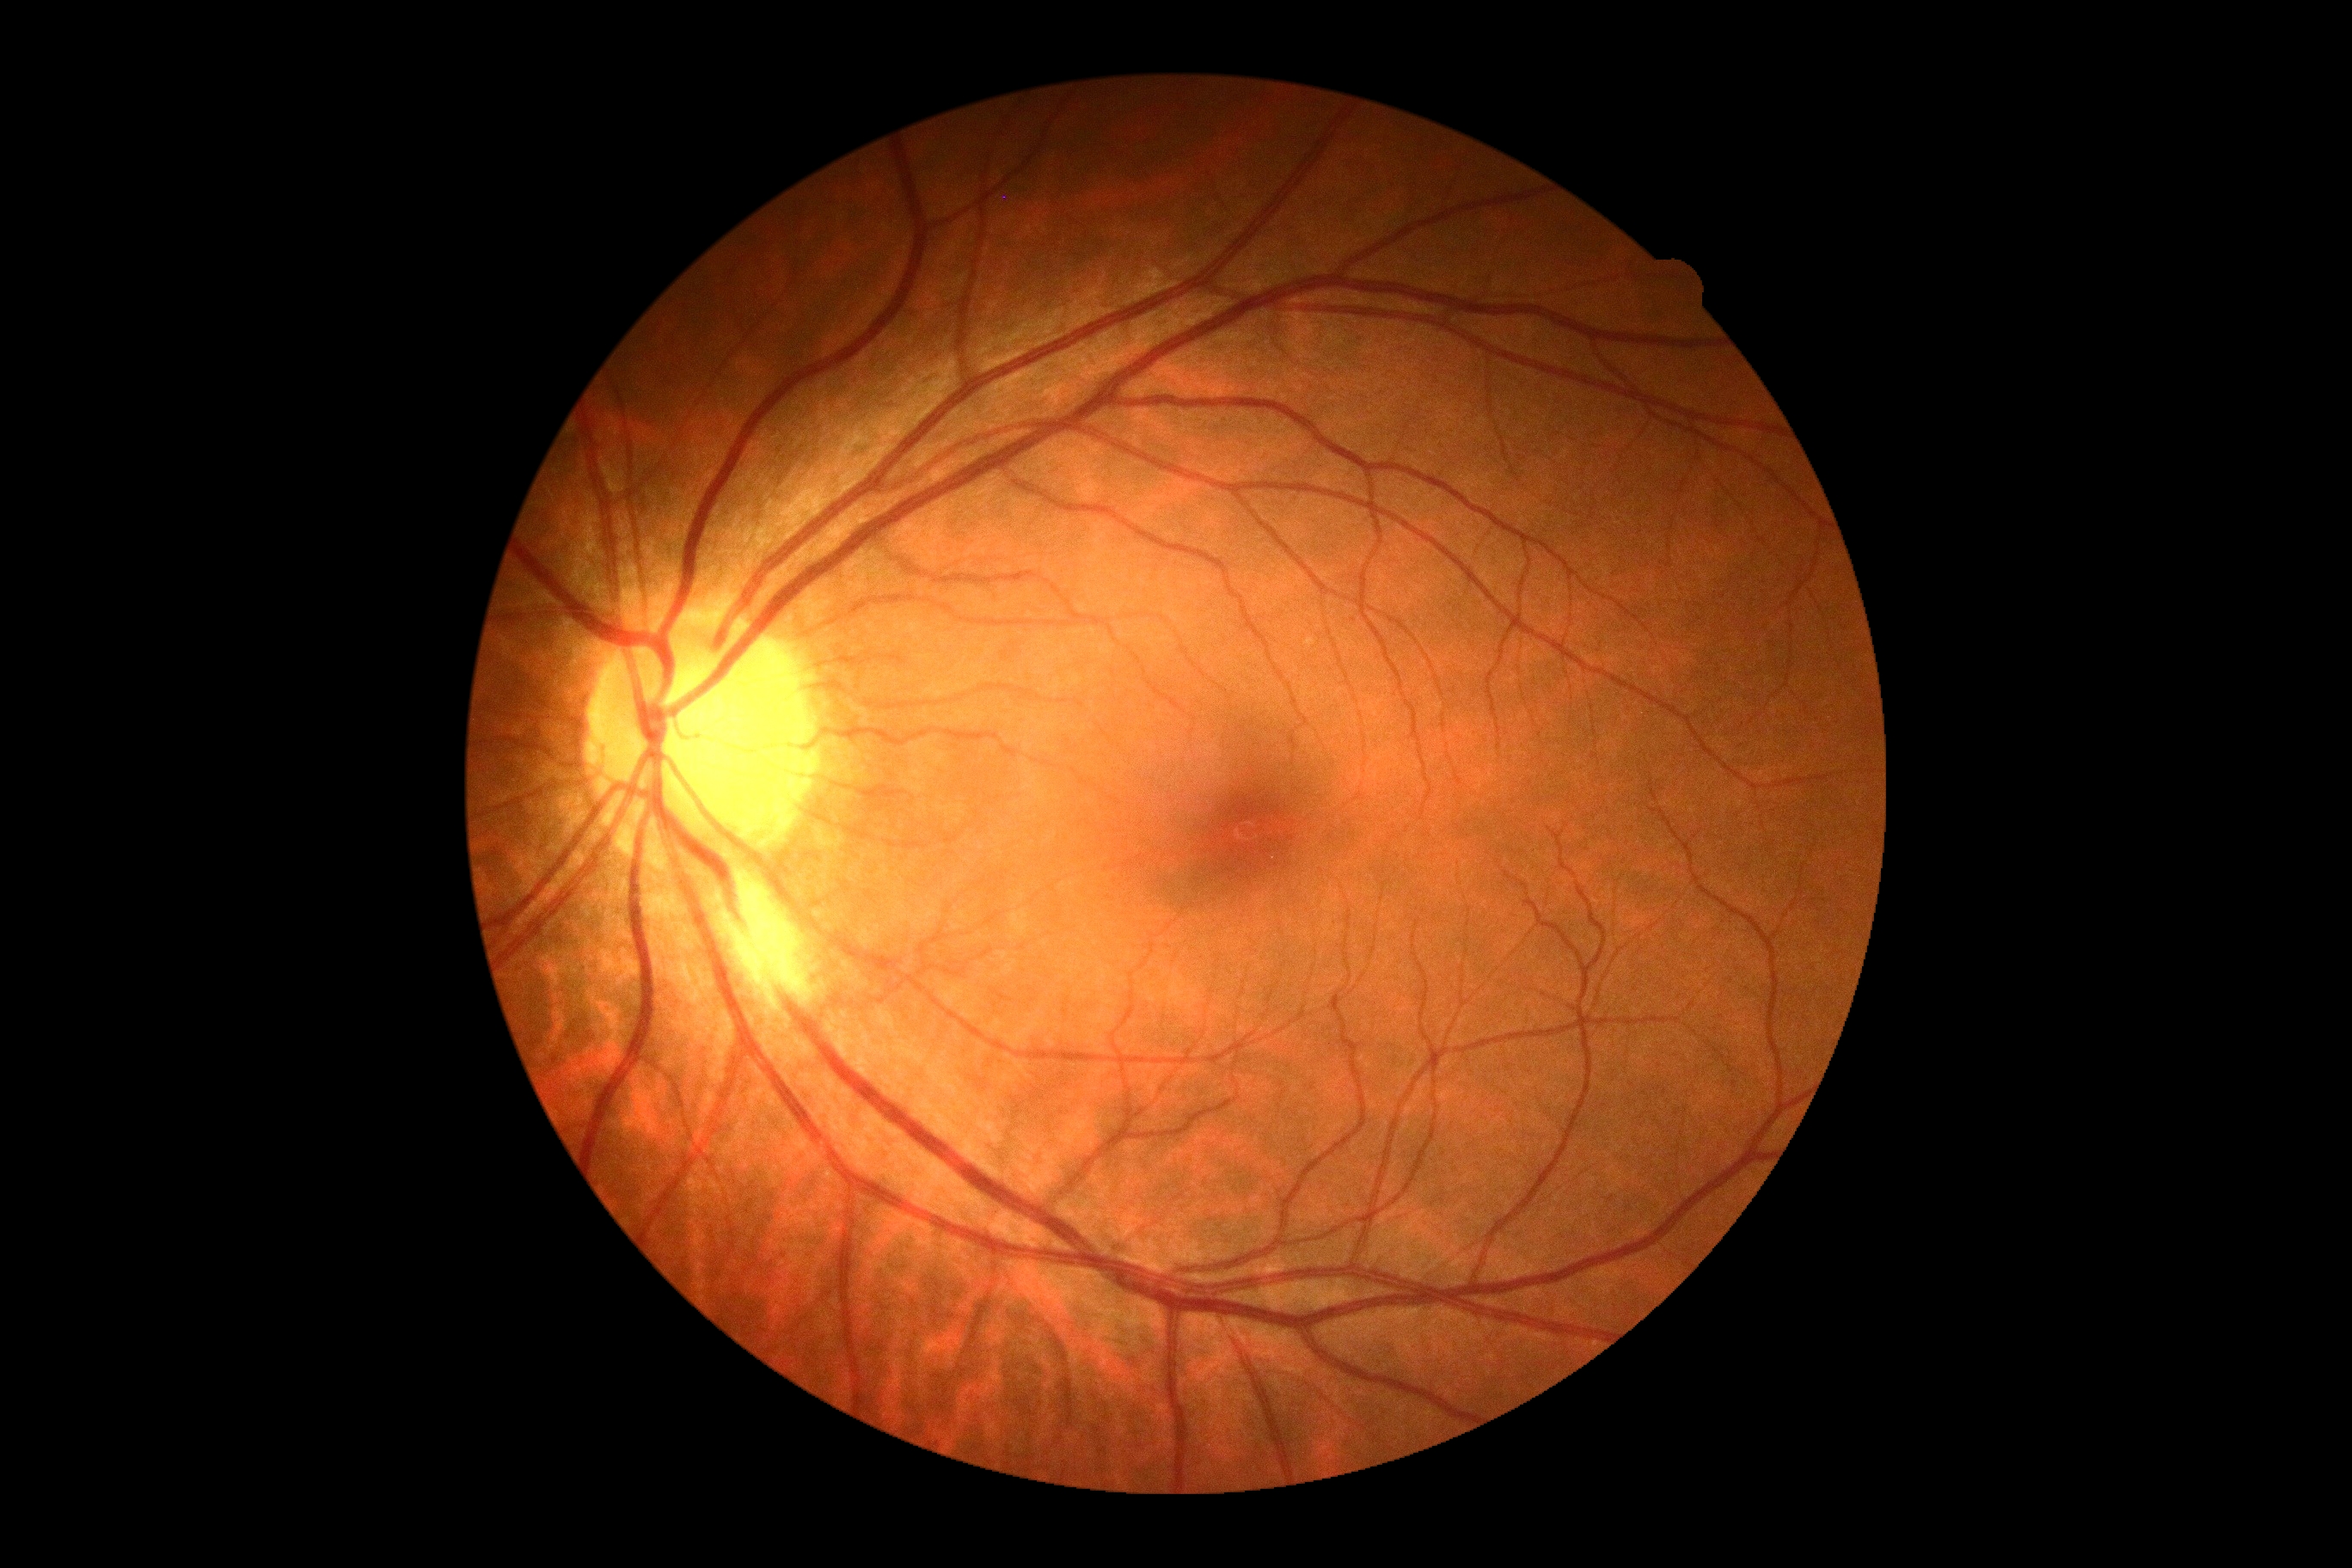
DR severity@grade 0 (no apparent retinopathy).